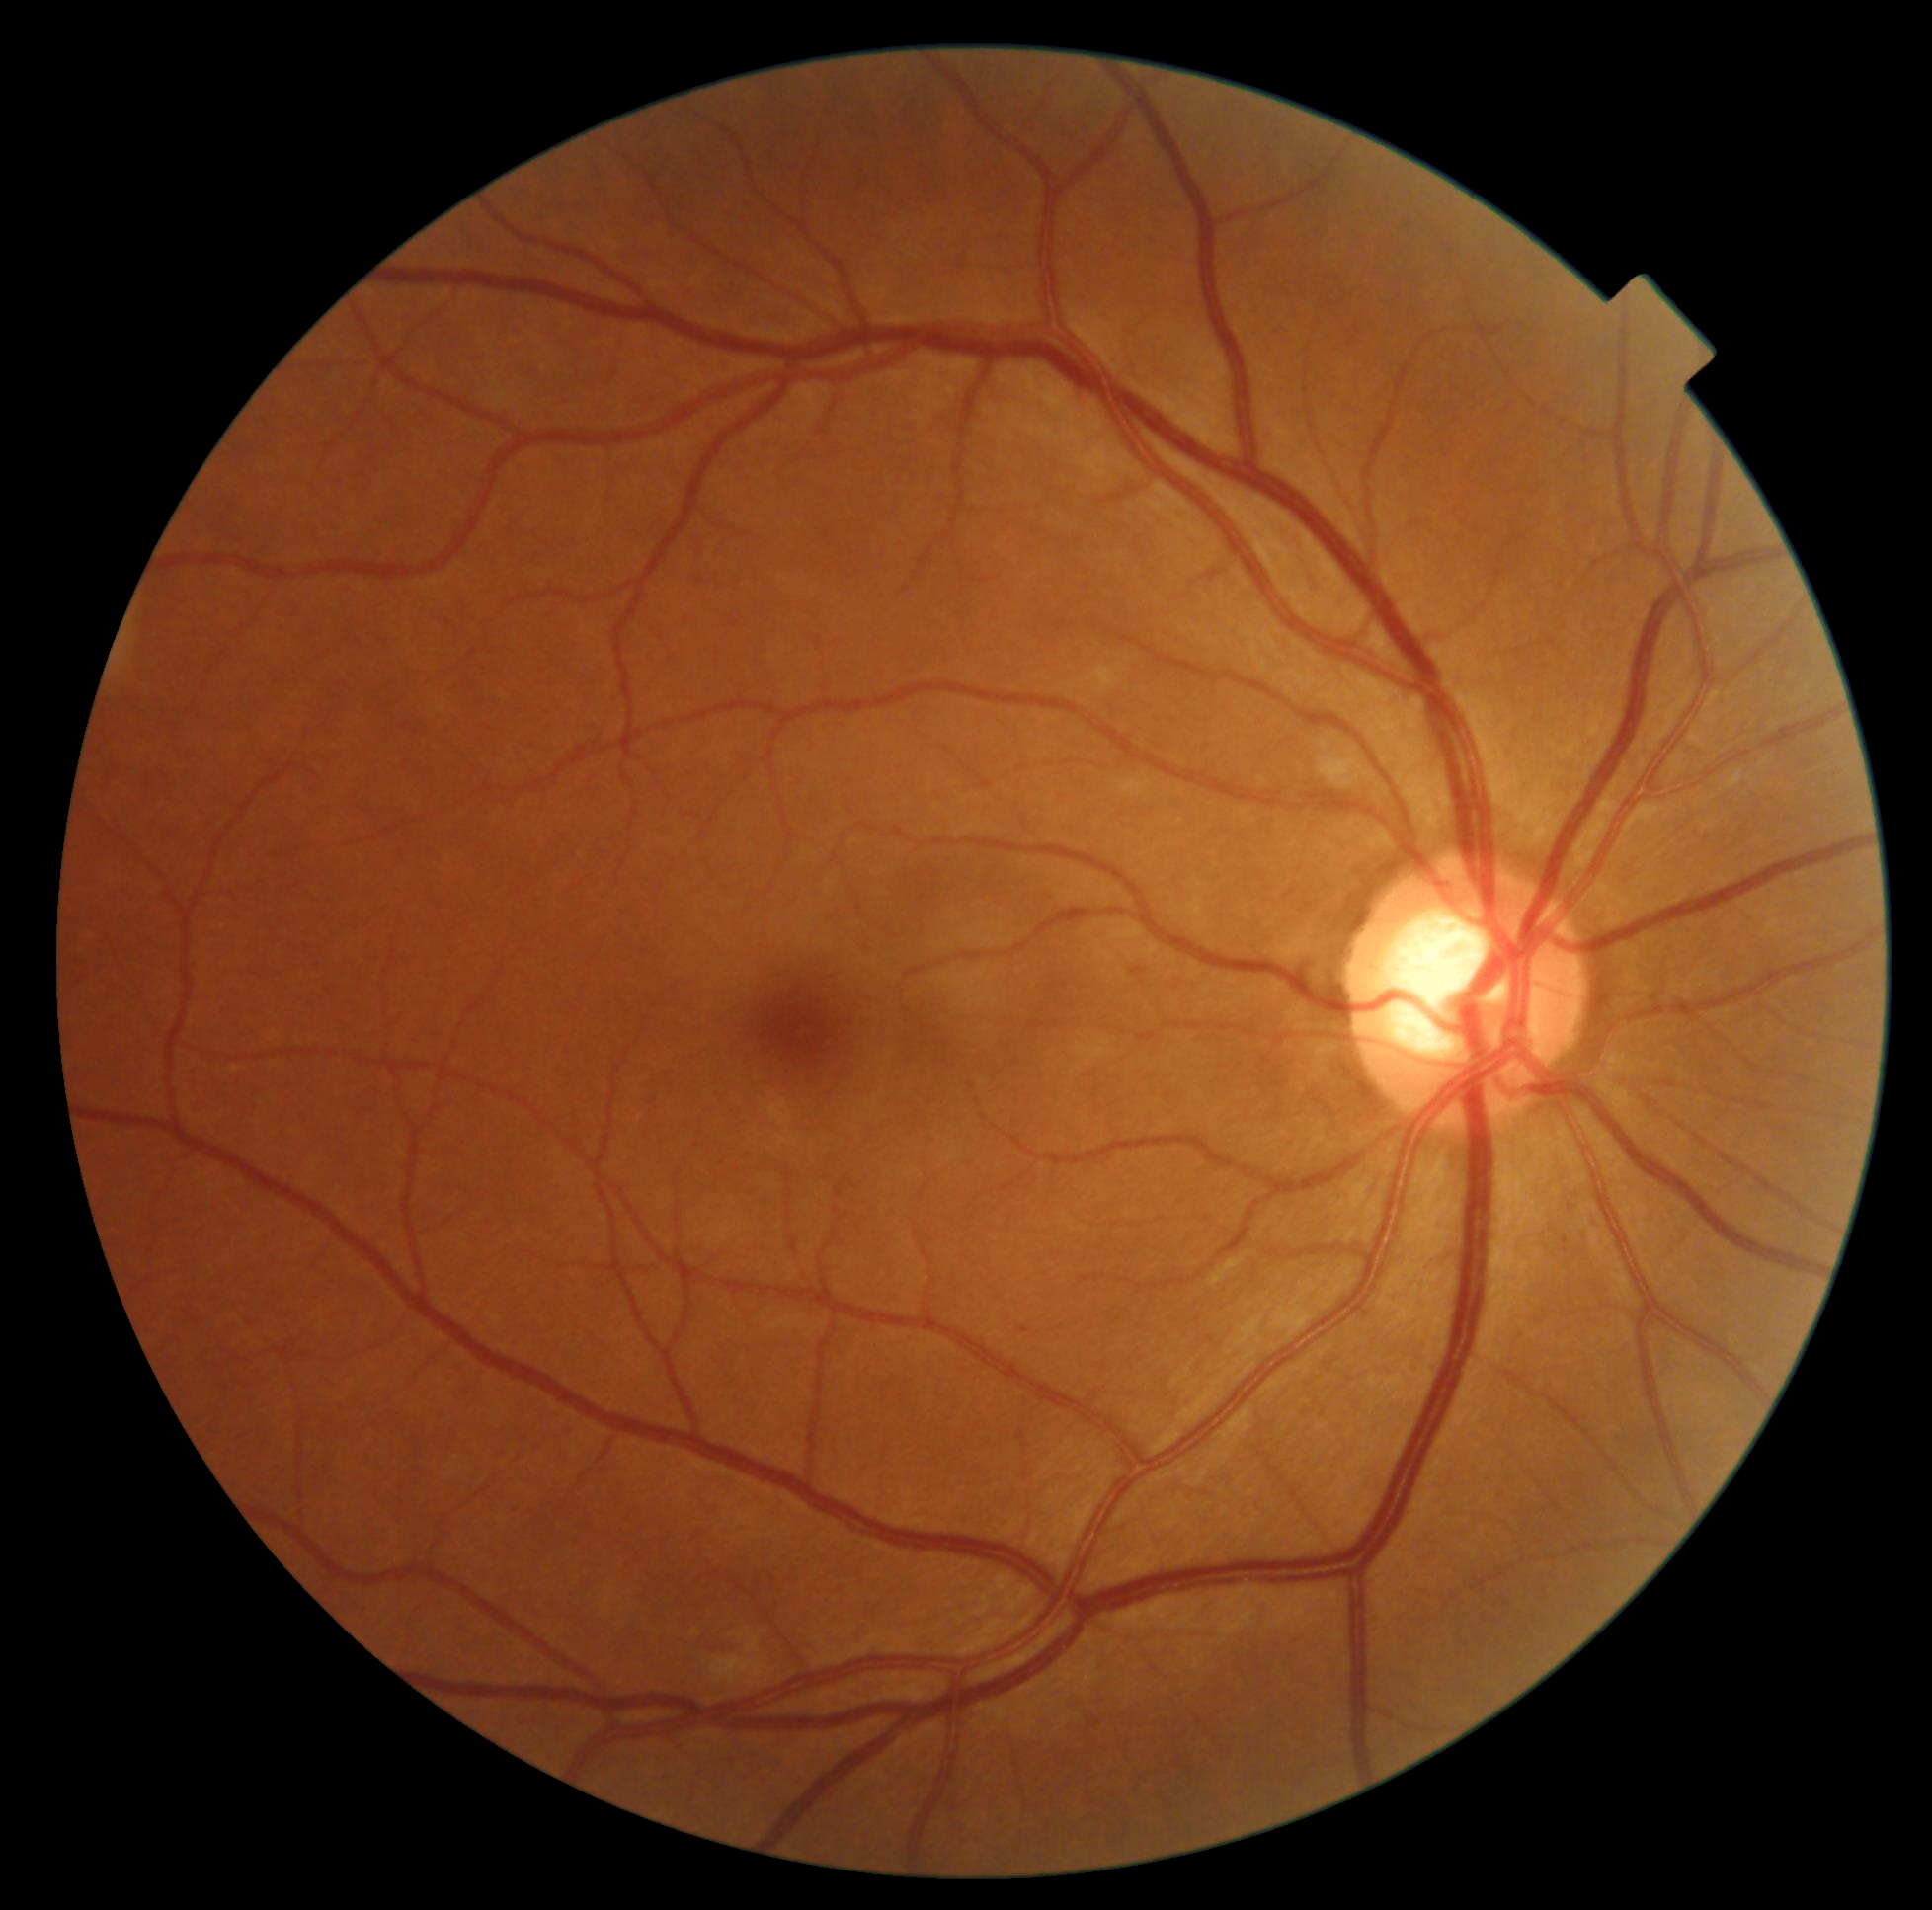 dr_grade: moderate non-proliferative diabetic retinopathy (grade 2)